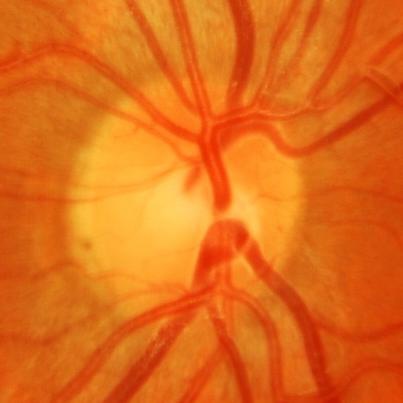 Impression: glaucomatous damage to the optic nerve.